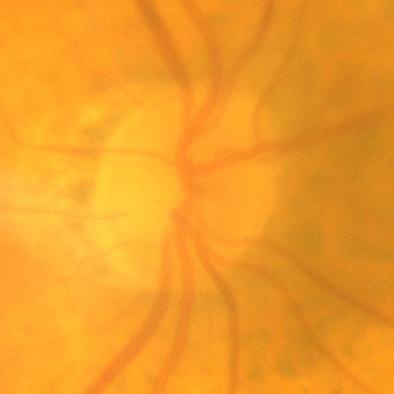

Optic nerve head appearance consistent with no evidence of glaucoma.